45-degree field of view:
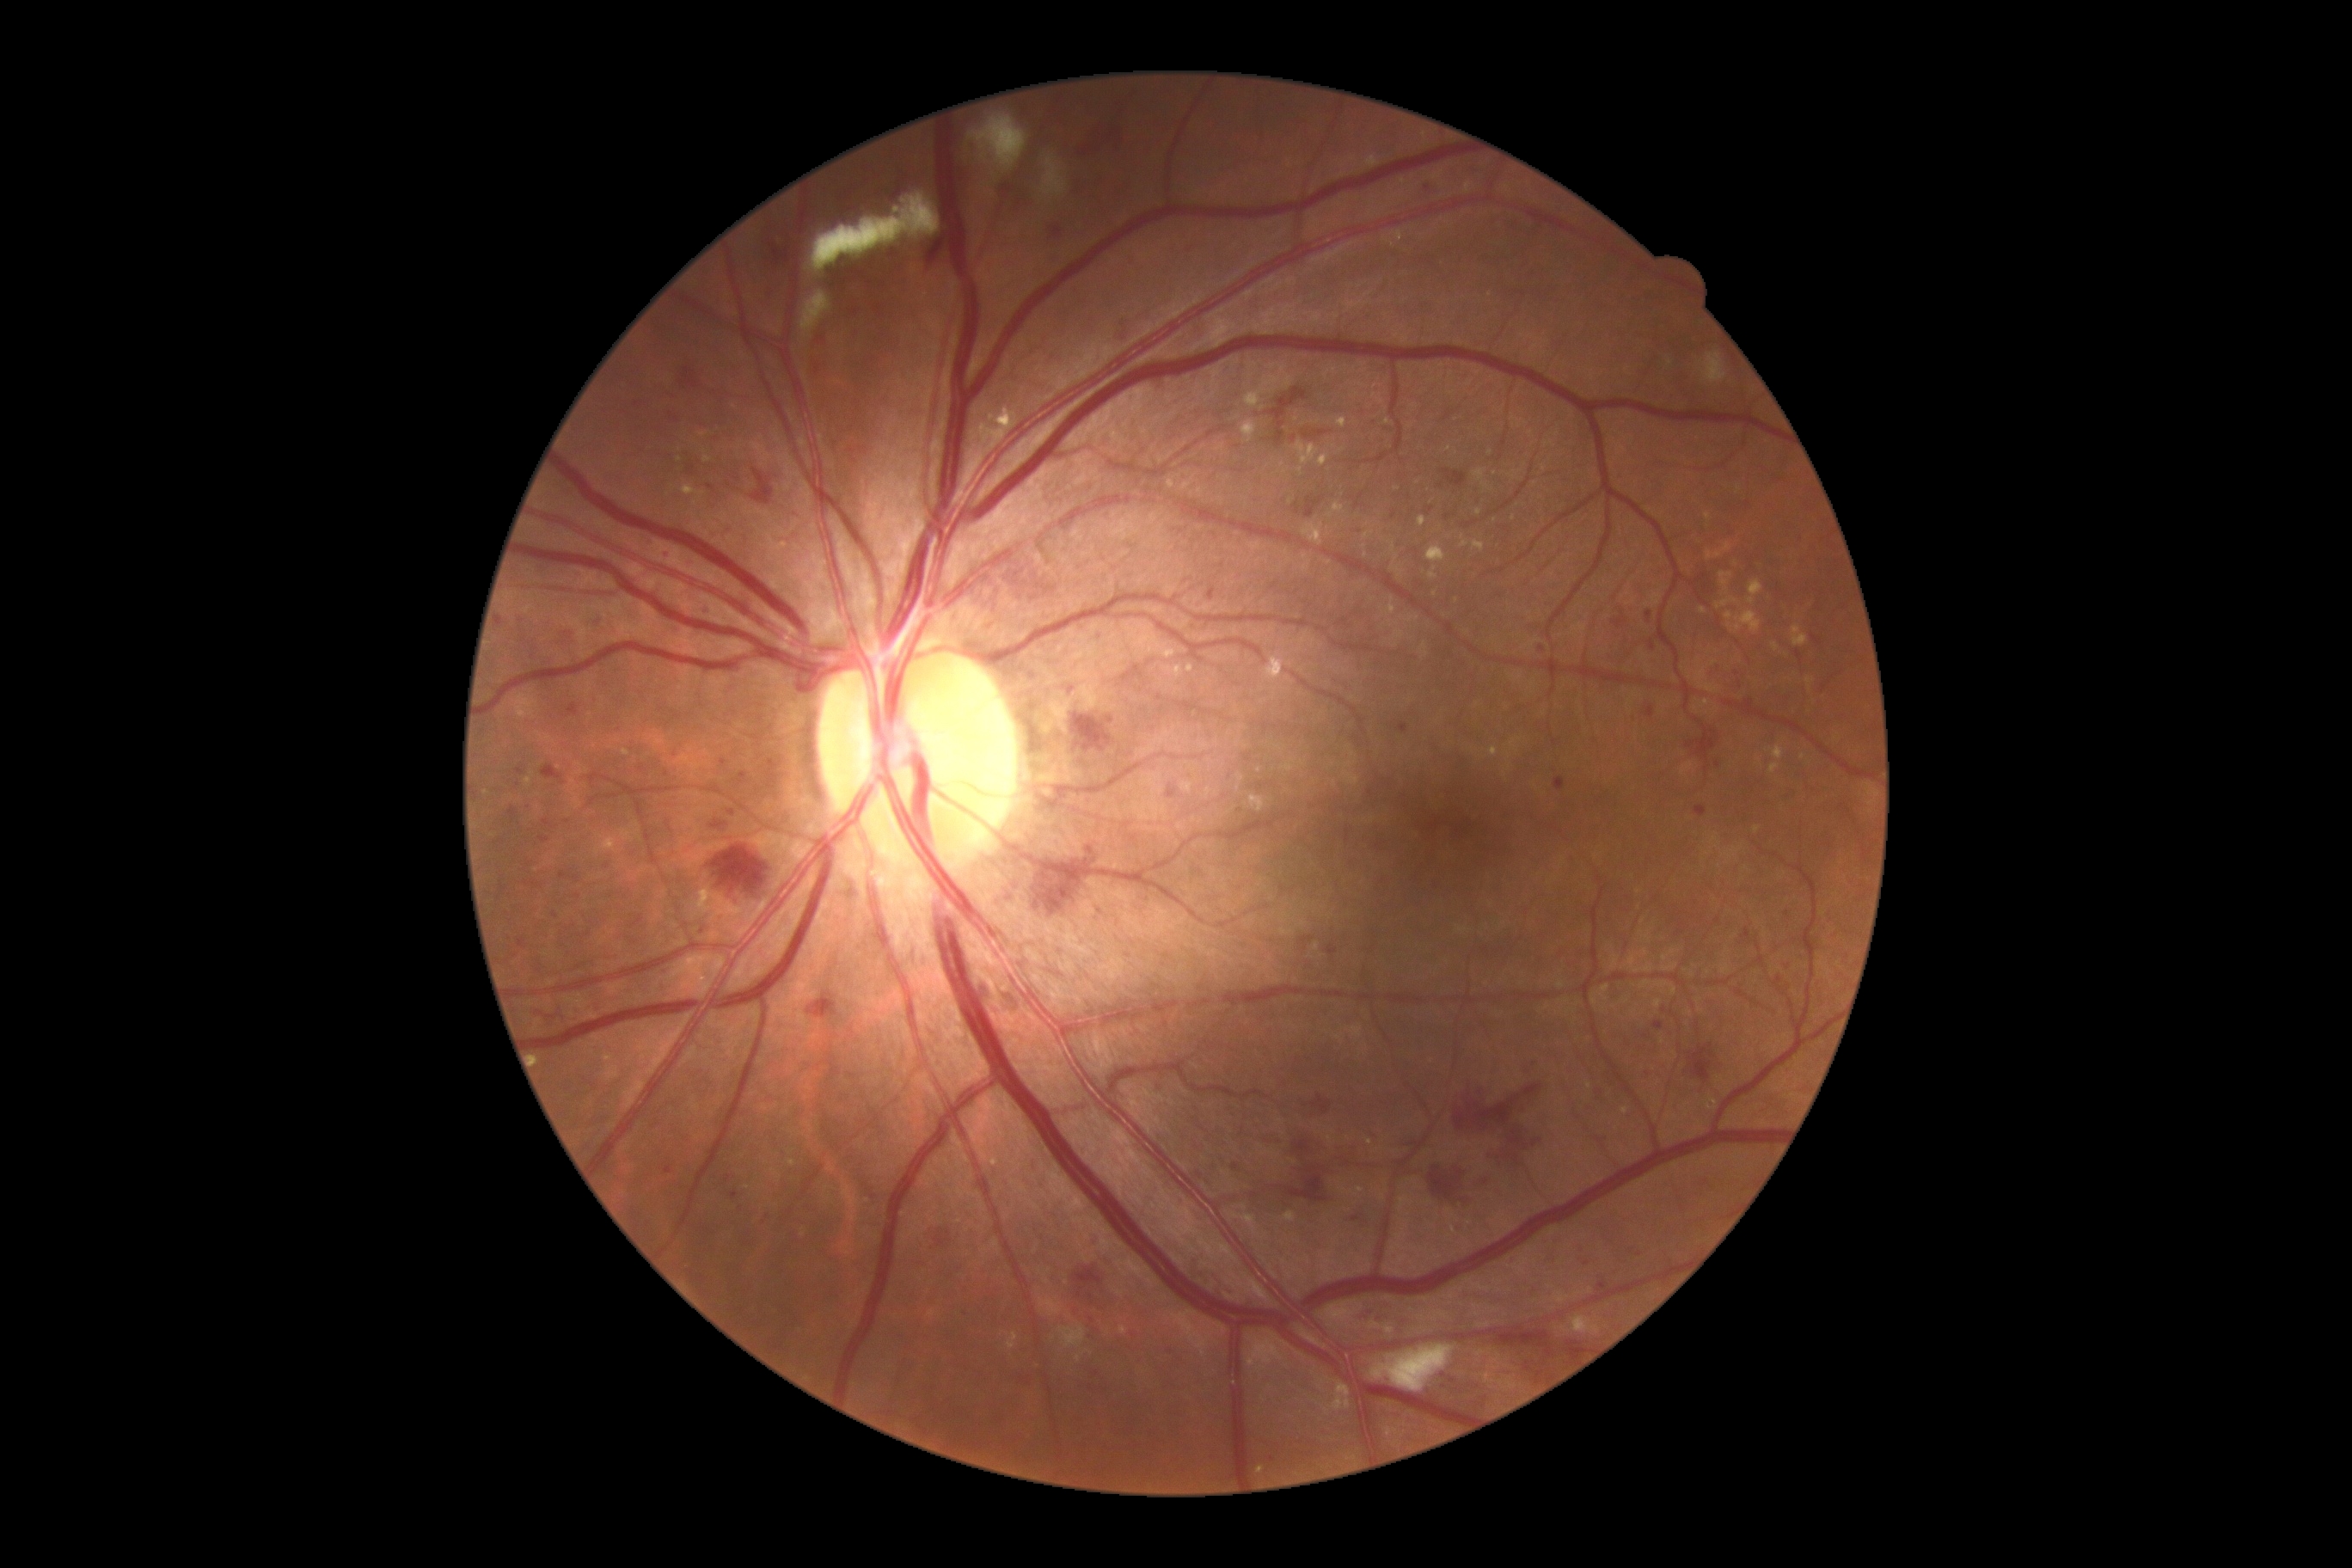
Retinopathy grade is 3 (severe NPDR)
A subset of detected lesions:
microaneurysms (more not shown): bbox=[1464, 522, 1476, 529]; bbox=[740, 773, 747, 781]; bbox=[508, 807, 518, 823]; bbox=[1784, 793, 1799, 800]; bbox=[1244, 754, 1253, 763]; bbox=[1120, 322, 1132, 341]; bbox=[1510, 1259, 1519, 1266]; bbox=[1646, 609, 1651, 623]; bbox=[1397, 723, 1409, 733]; bbox=[1304, 496, 1325, 518]; bbox=[1020, 1376, 1031, 1385]
Additional small microaneurysms near x=555, y=916; x=607, y=866; x=1161, y=1090; x=1486, y=1182; x=1272, y=1459; x=1640, y=1255; x=1349, y=1164; x=678, y=717; x=530, y=865
hemorrhages (more not shown): bbox=[534, 1007, 558, 1024]; bbox=[707, 843, 778, 903]; bbox=[1689, 1044, 1715, 1082]; bbox=[541, 766, 563, 780]; bbox=[1287, 1173, 1333, 1206]; bbox=[1304, 431, 1330, 439]; bbox=[1266, 1129, 1356, 1170]; bbox=[1070, 716, 1120, 750]; bbox=[769, 243, 793, 267]; bbox=[1270, 388, 1308, 448]; bbox=[967, 584, 1003, 616]; bbox=[1430, 1167, 1466, 1201]; bbox=[926, 233, 948, 267]
hard exudates (more not shown): bbox=[1185, 665, 1194, 675]; bbox=[1302, 524, 1325, 548]; bbox=[1672, 986, 1677, 996]; bbox=[1351, 1027, 1363, 1038]; bbox=[1593, 986, 1610, 1007]; bbox=[1163, 666, 1184, 680]; bbox=[1717, 599, 1739, 609]; bbox=[1653, 1000, 1662, 1008]; bbox=[1318, 453, 1330, 467]; bbox=[1705, 513, 1710, 522]; bbox=[981, 408, 1015, 450]; bbox=[1120, 1326, 1127, 1335]
Additional small hard exudates near x=579, y=765; x=1513, y=519; x=487, y=793; x=1641, y=932; x=1297, y=419; x=1479, y=513